FOV: 45 degrees: 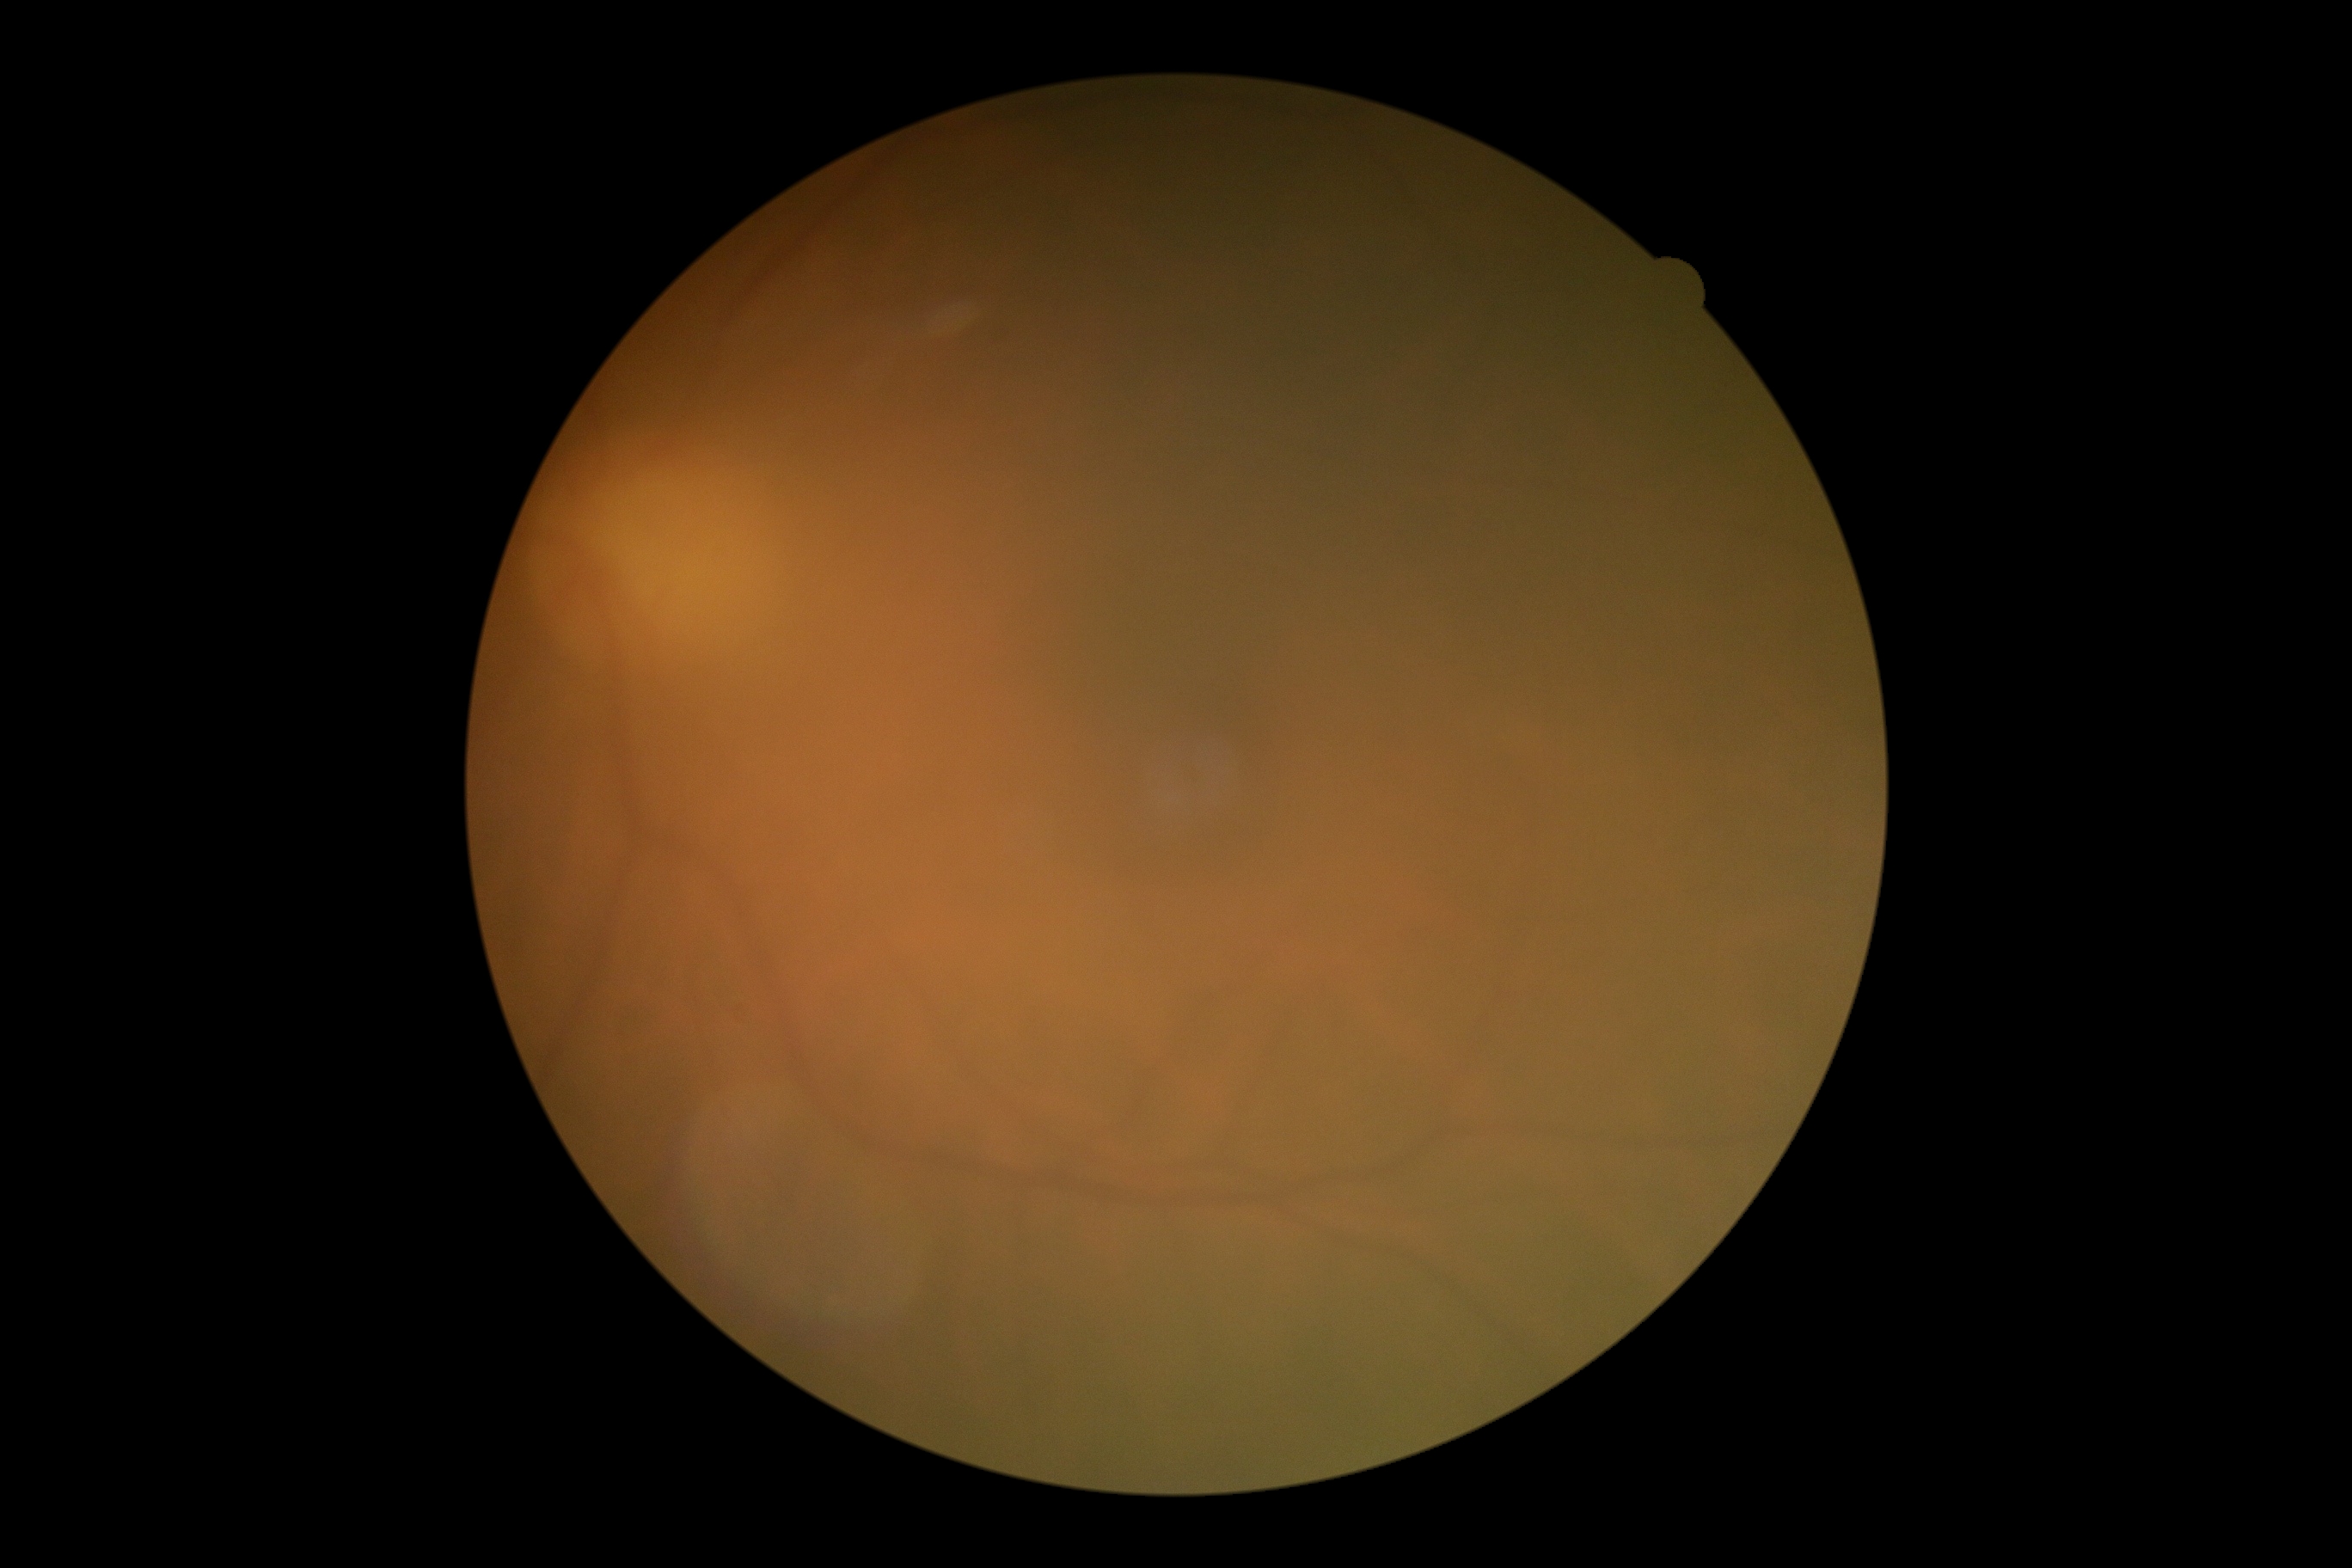

Retinopathy is 0/4.